Color fundus photograph. Image size 2102x1736 — 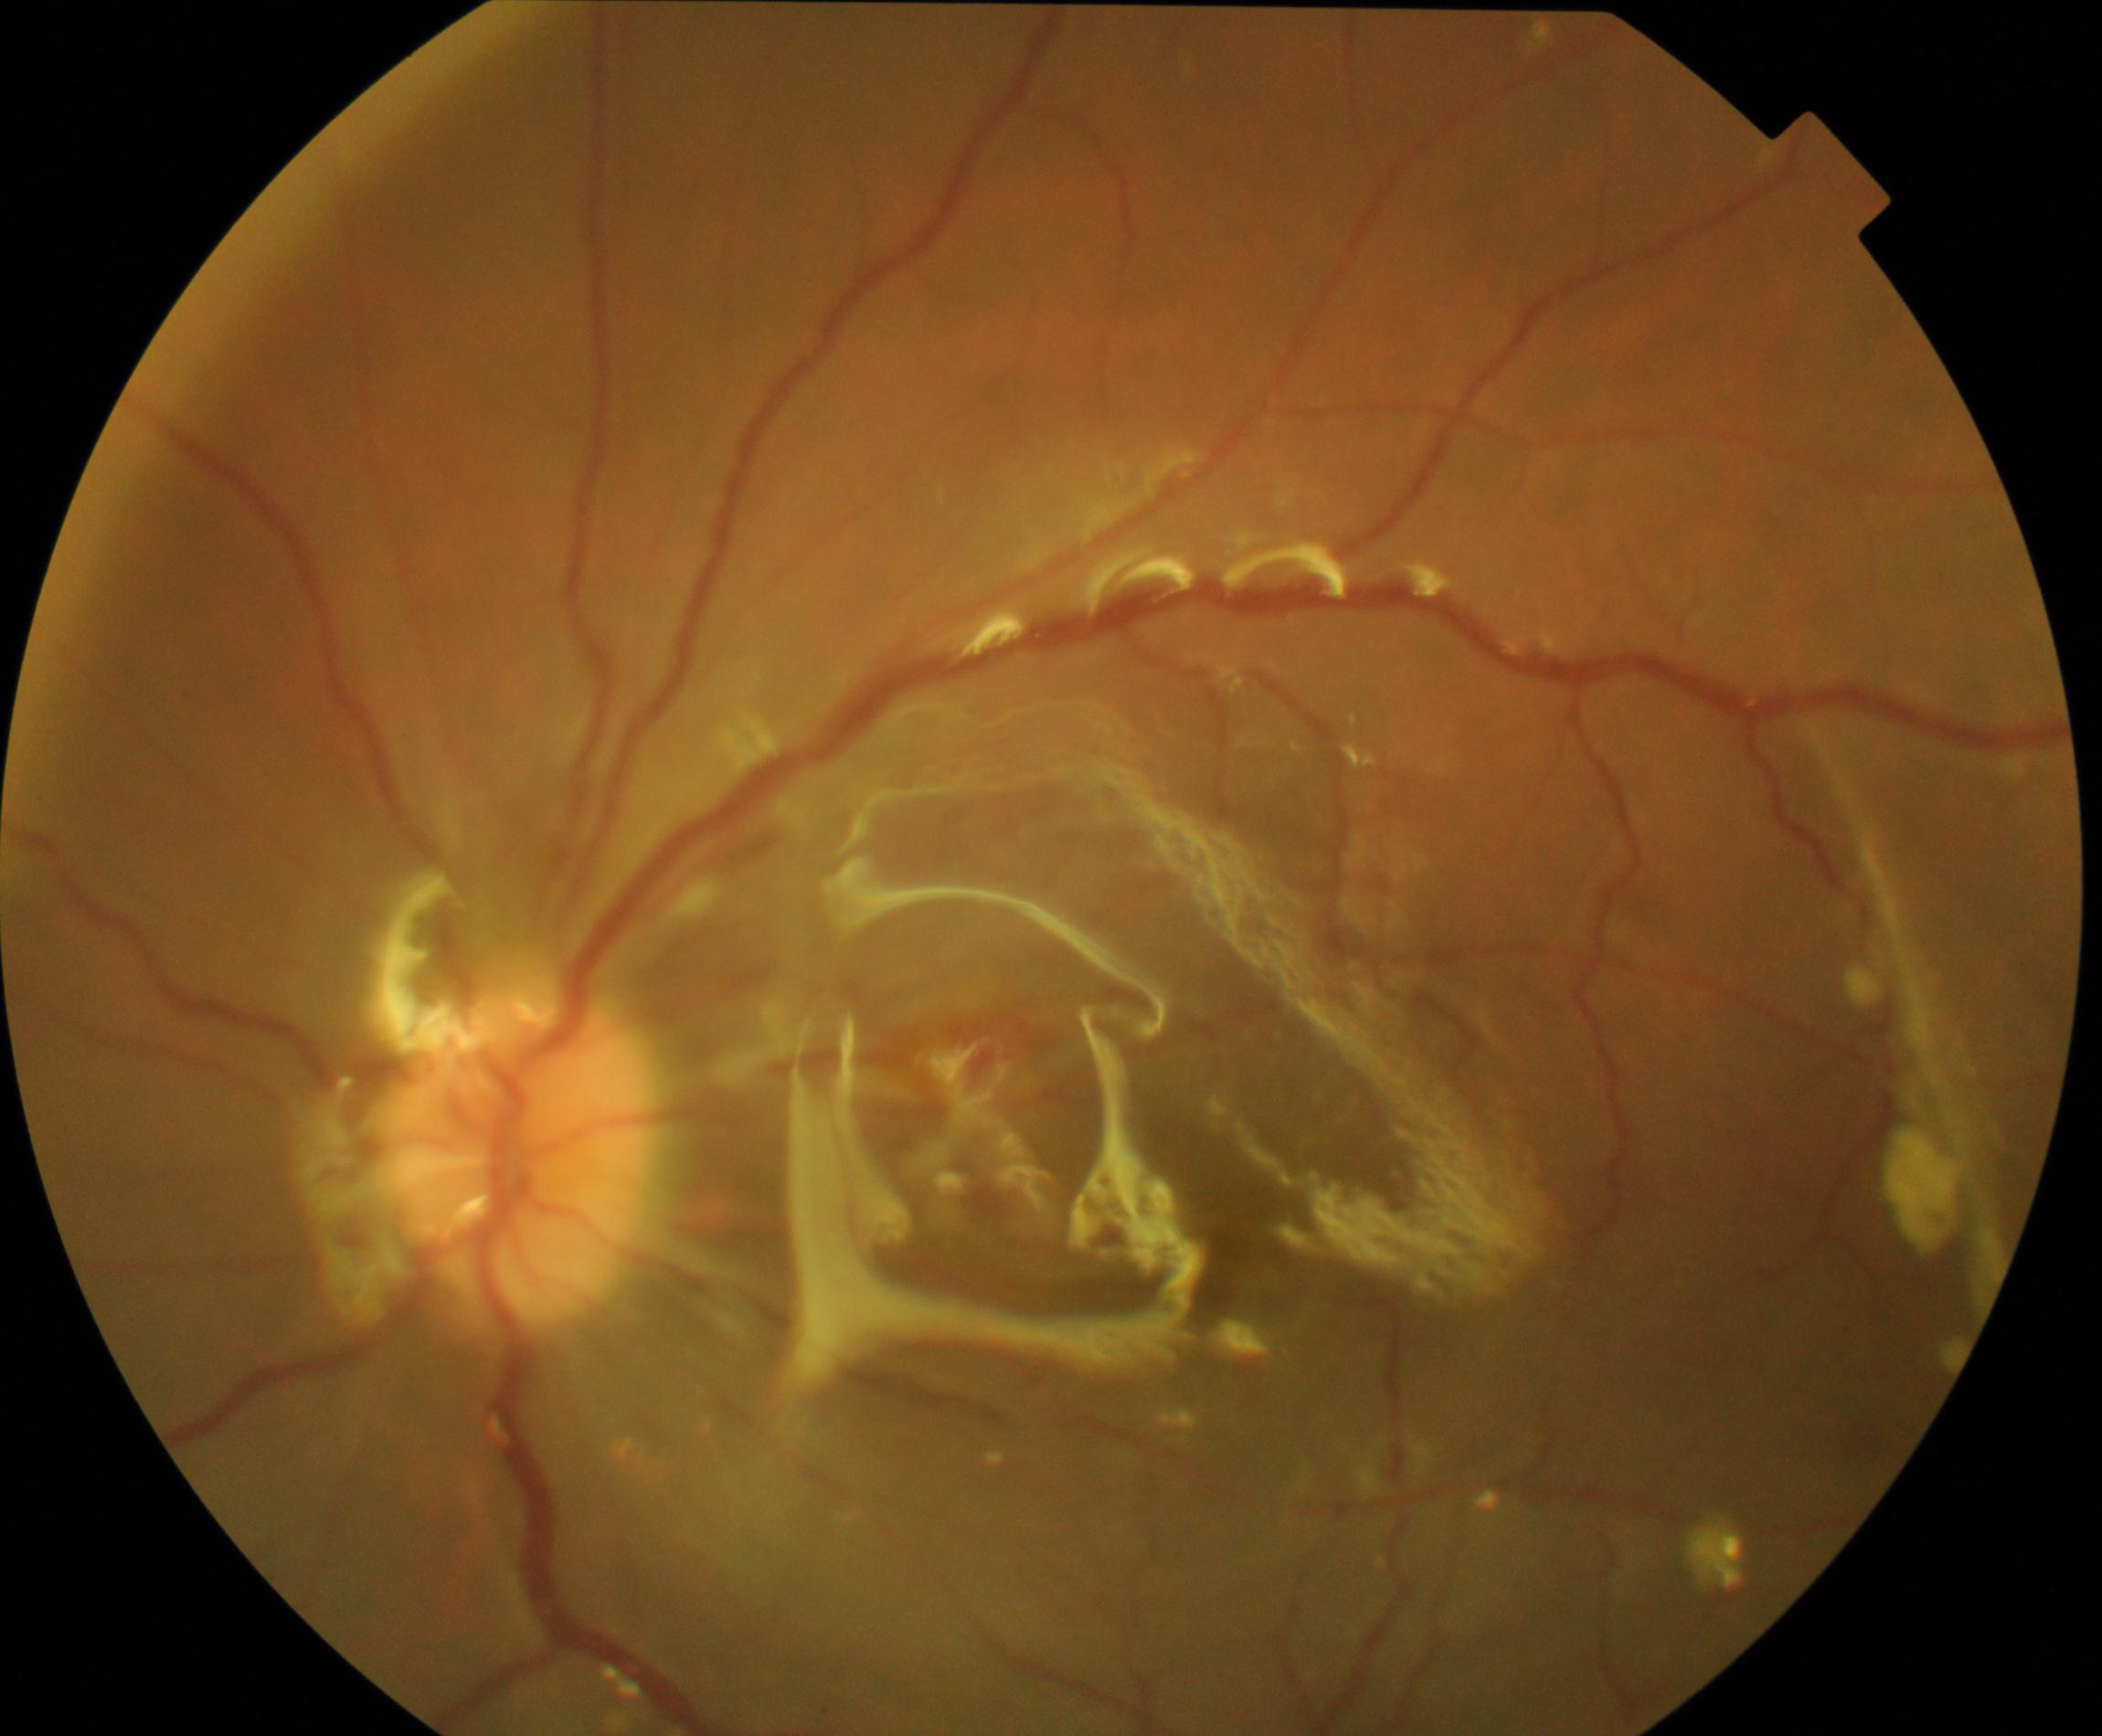
Findings: silicone oil in the eye.